Posterior pole photograph, 848 x 848 pixels — 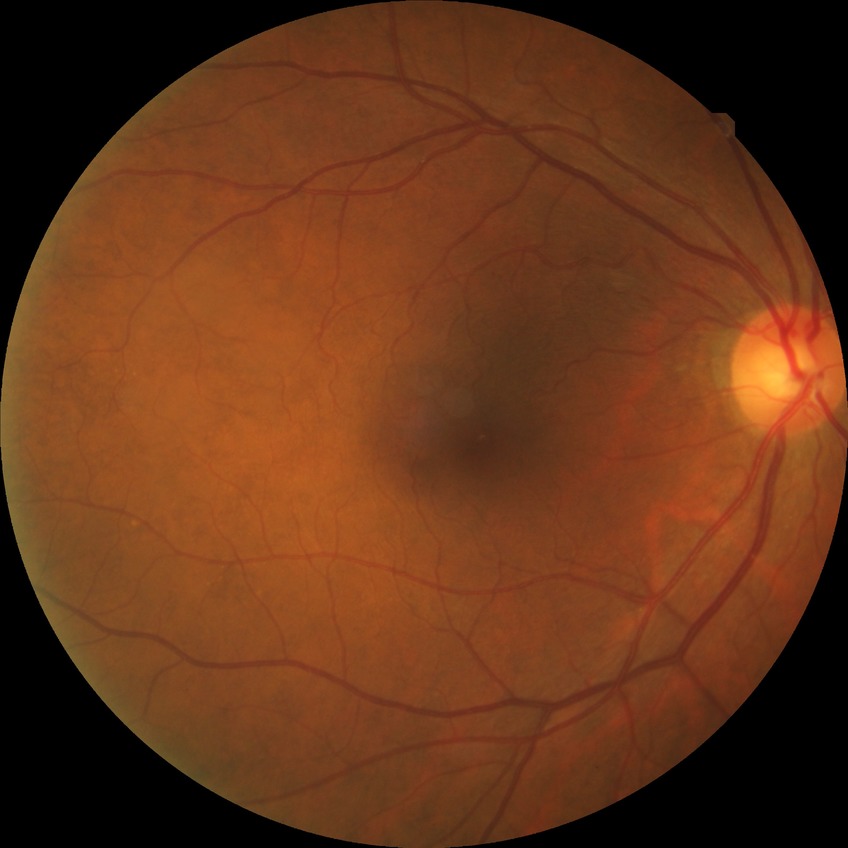

No signs of diabetic retinopathy. DR stage is NDR.